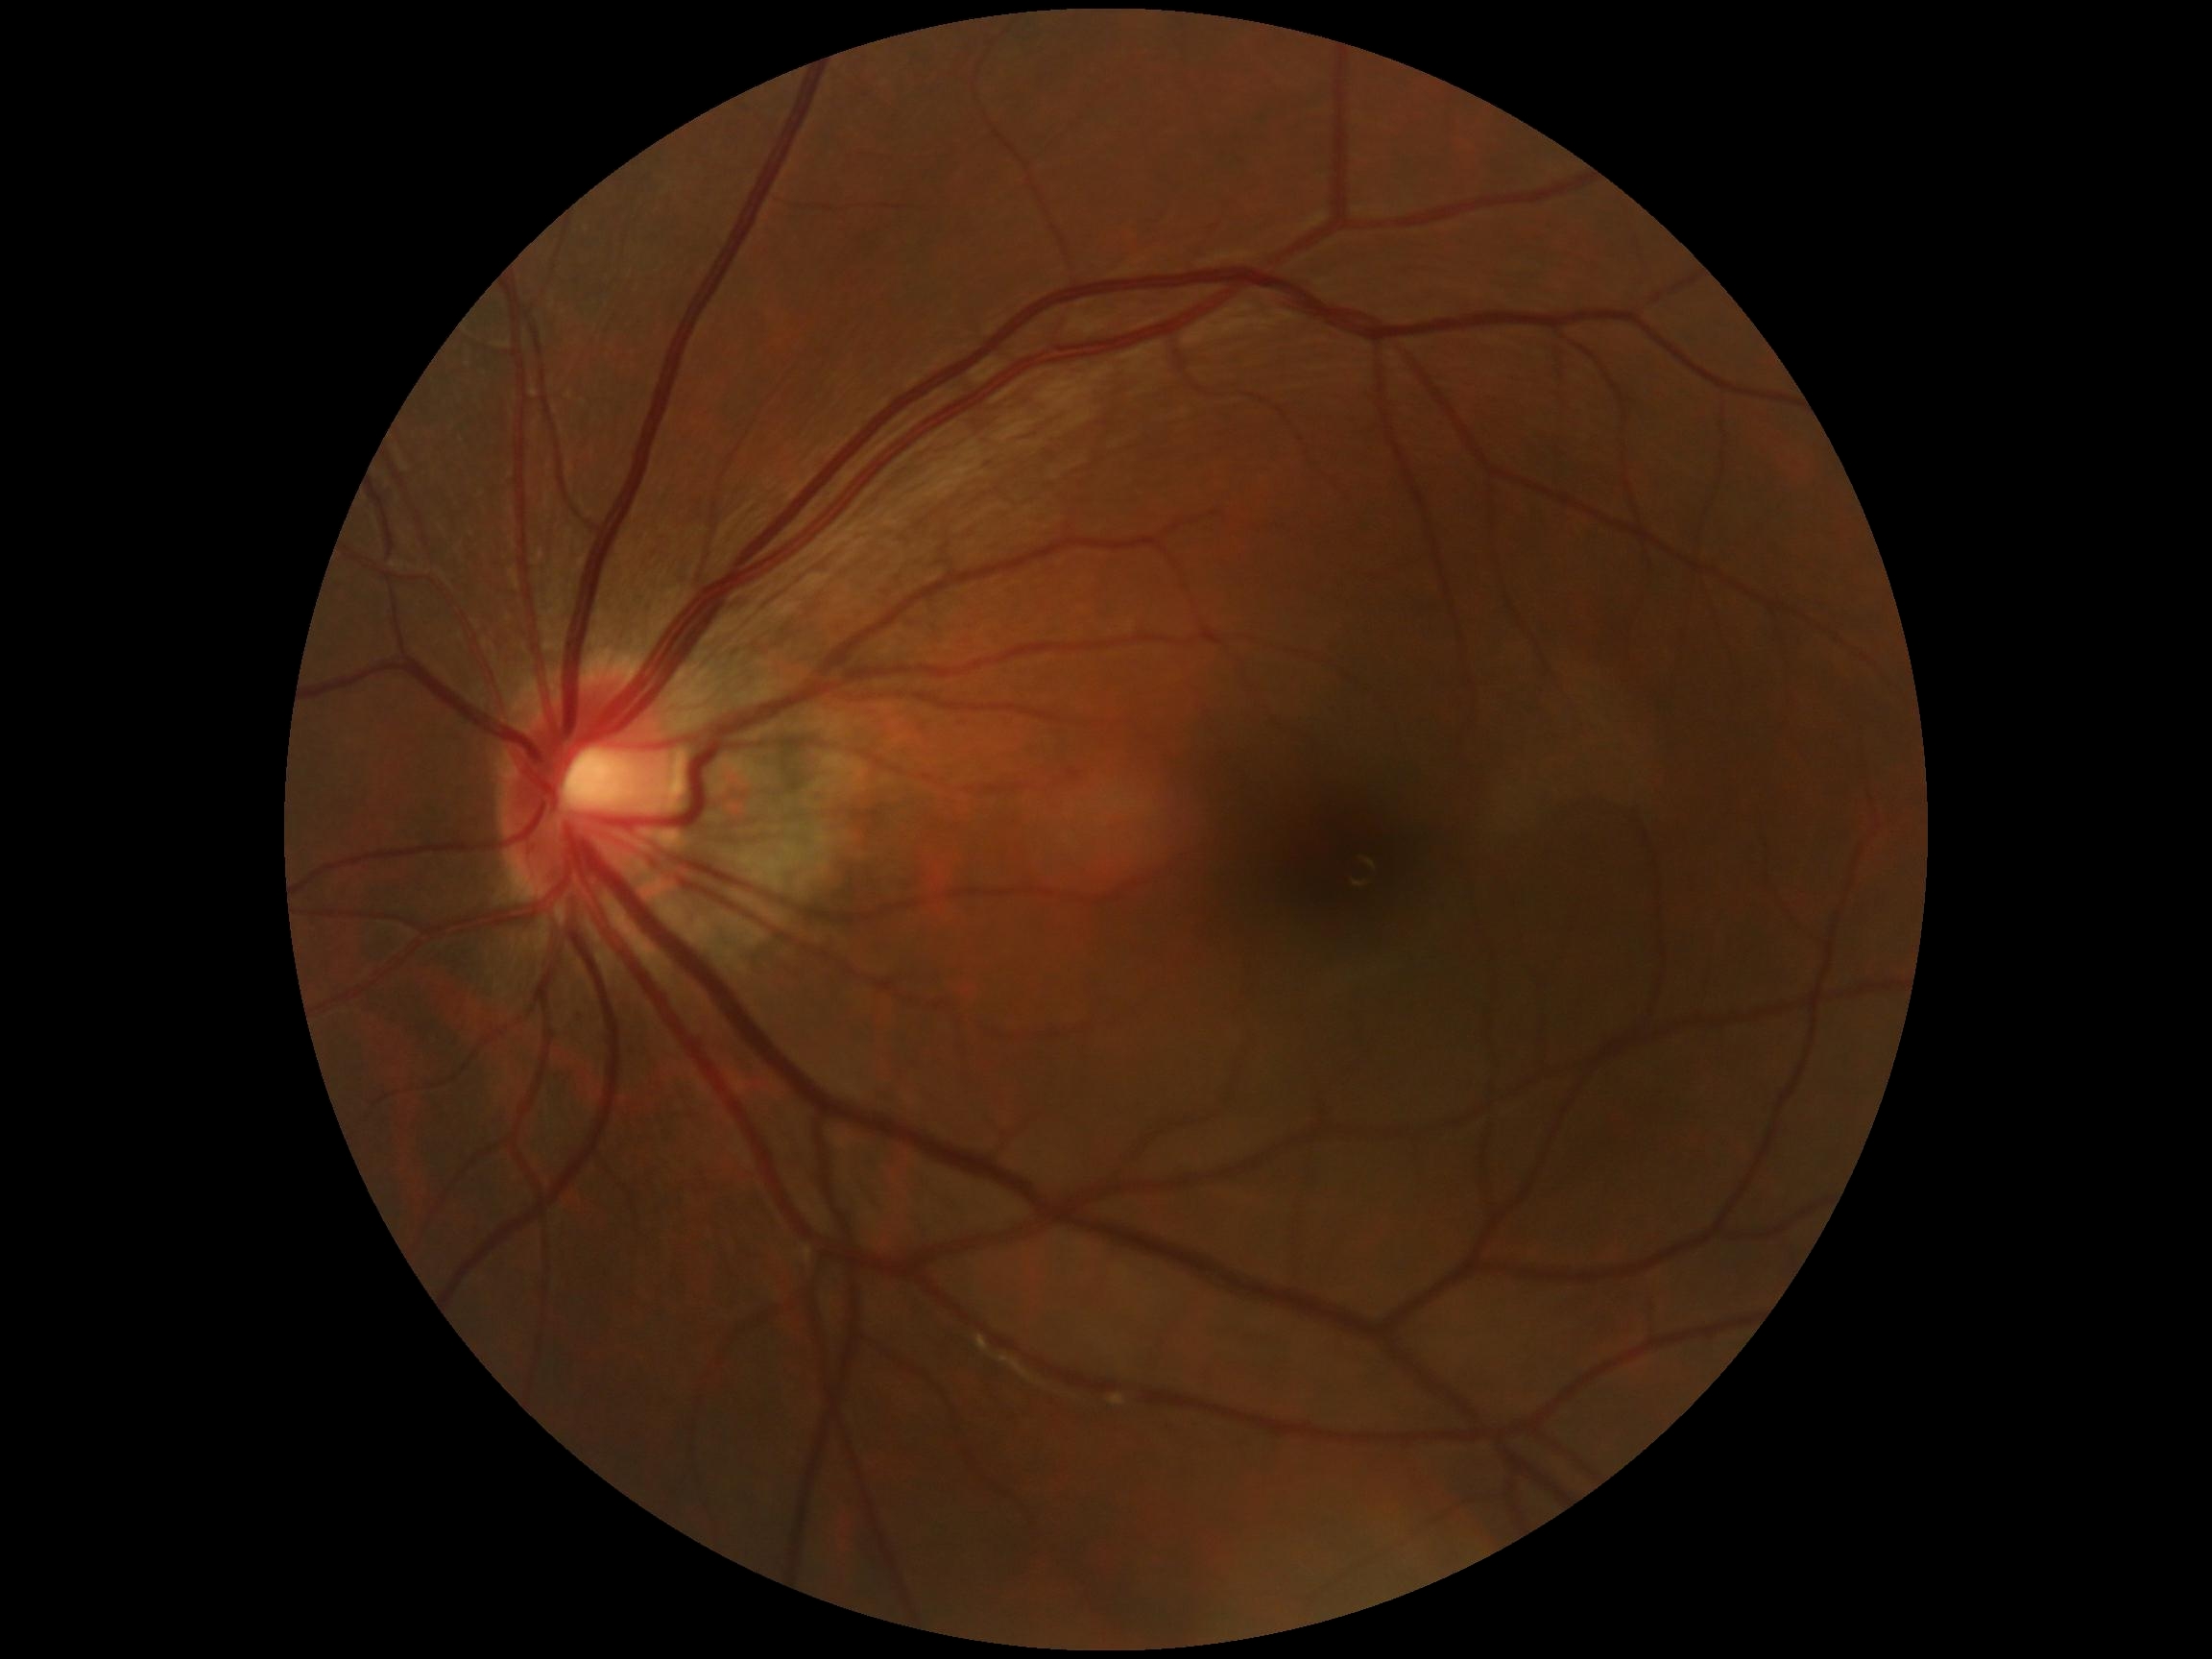
Findings:
• diabetic retinopathy: grade 0 (no apparent retinopathy)
• DR impression: no DR findings